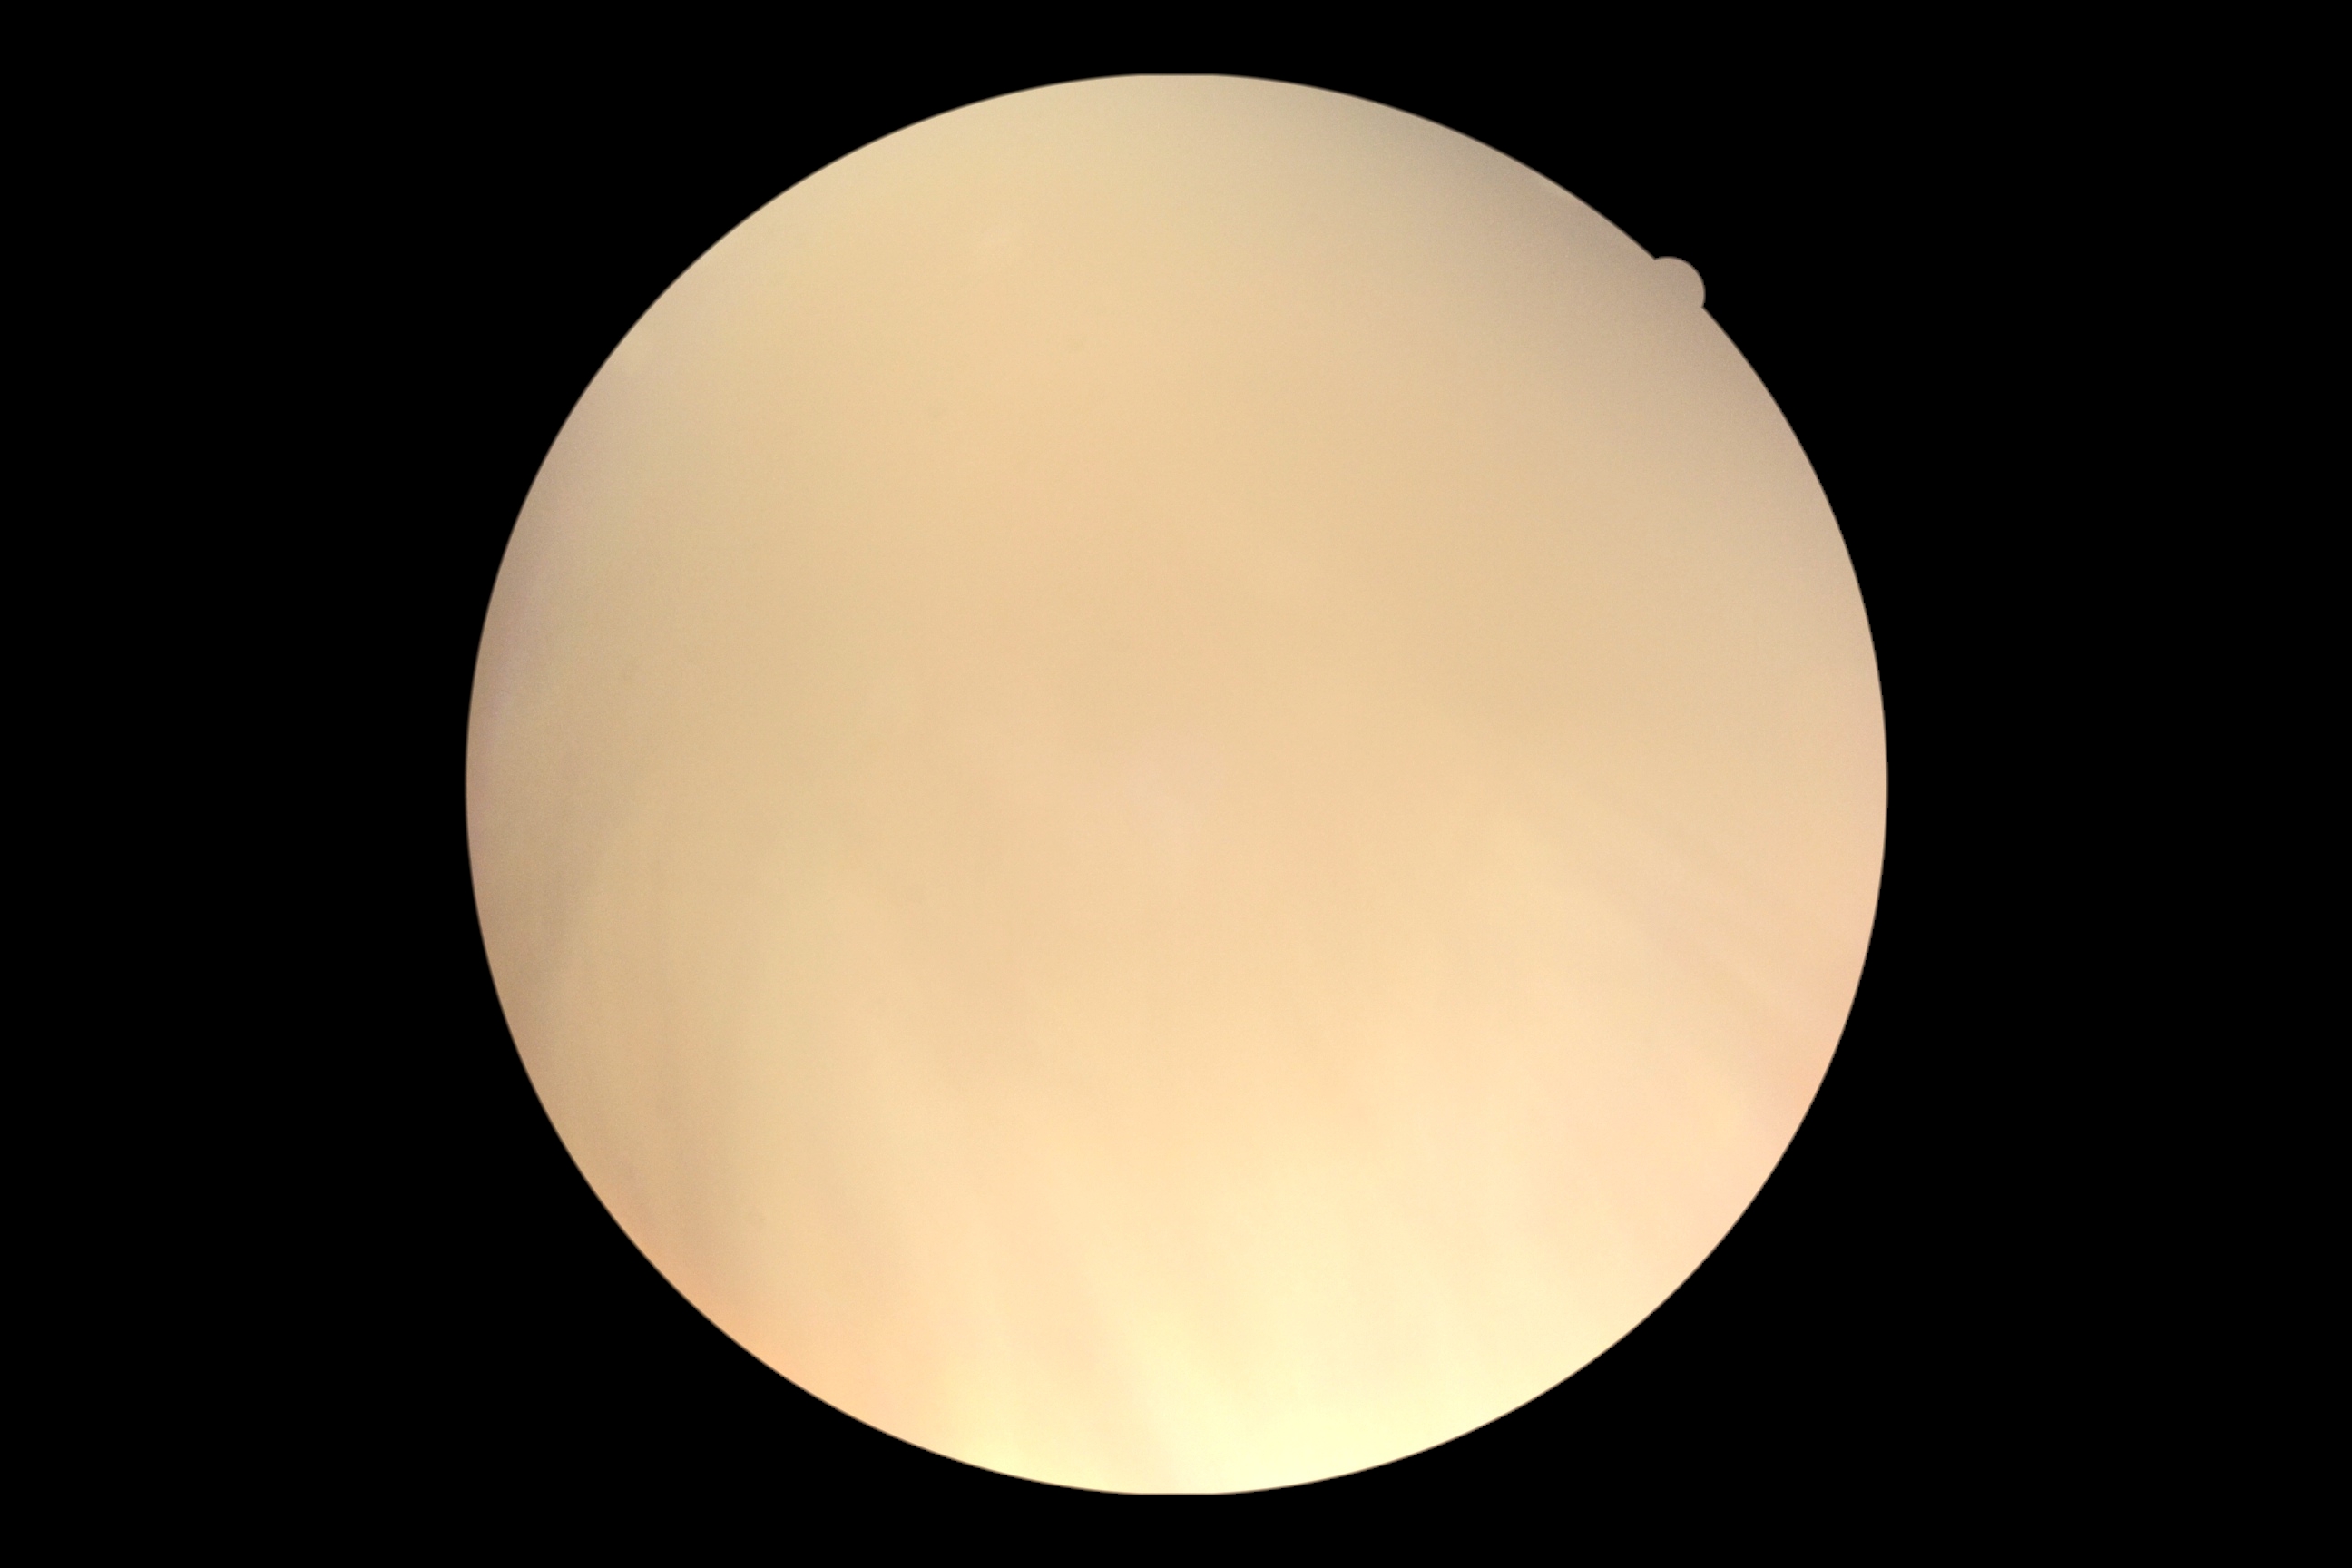

The image cannot be graded for diabetic retinopathy. Diabetic retinopathy is ungradable.